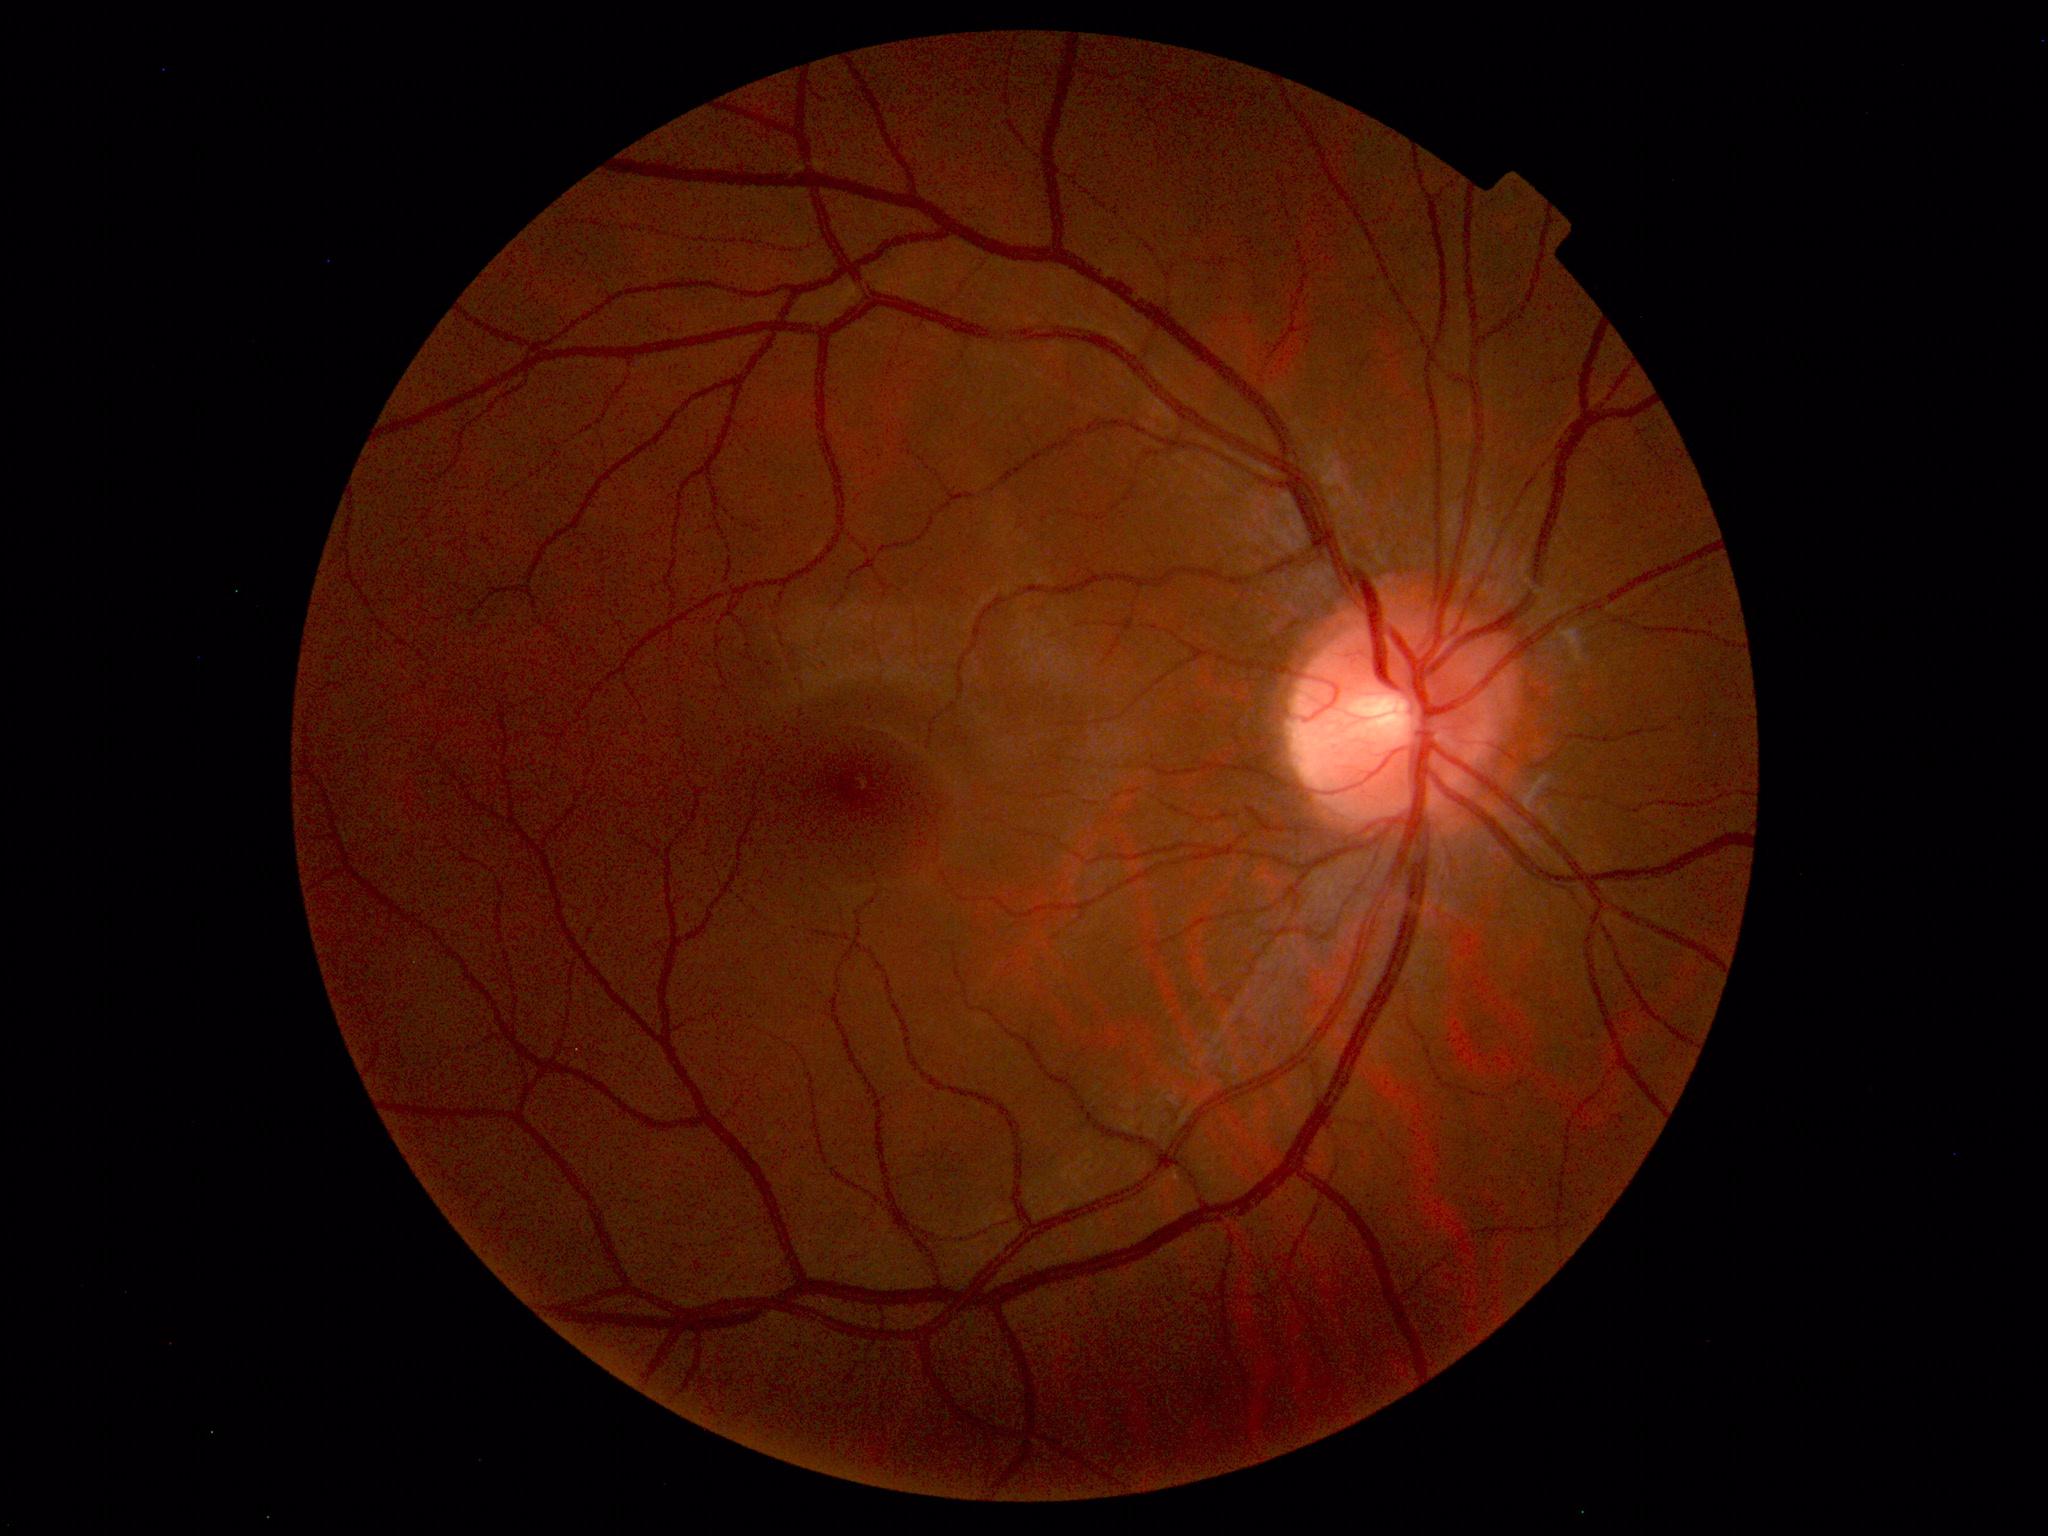 Normal fundus appearance.